1924x1556px. 200-degree field of view: 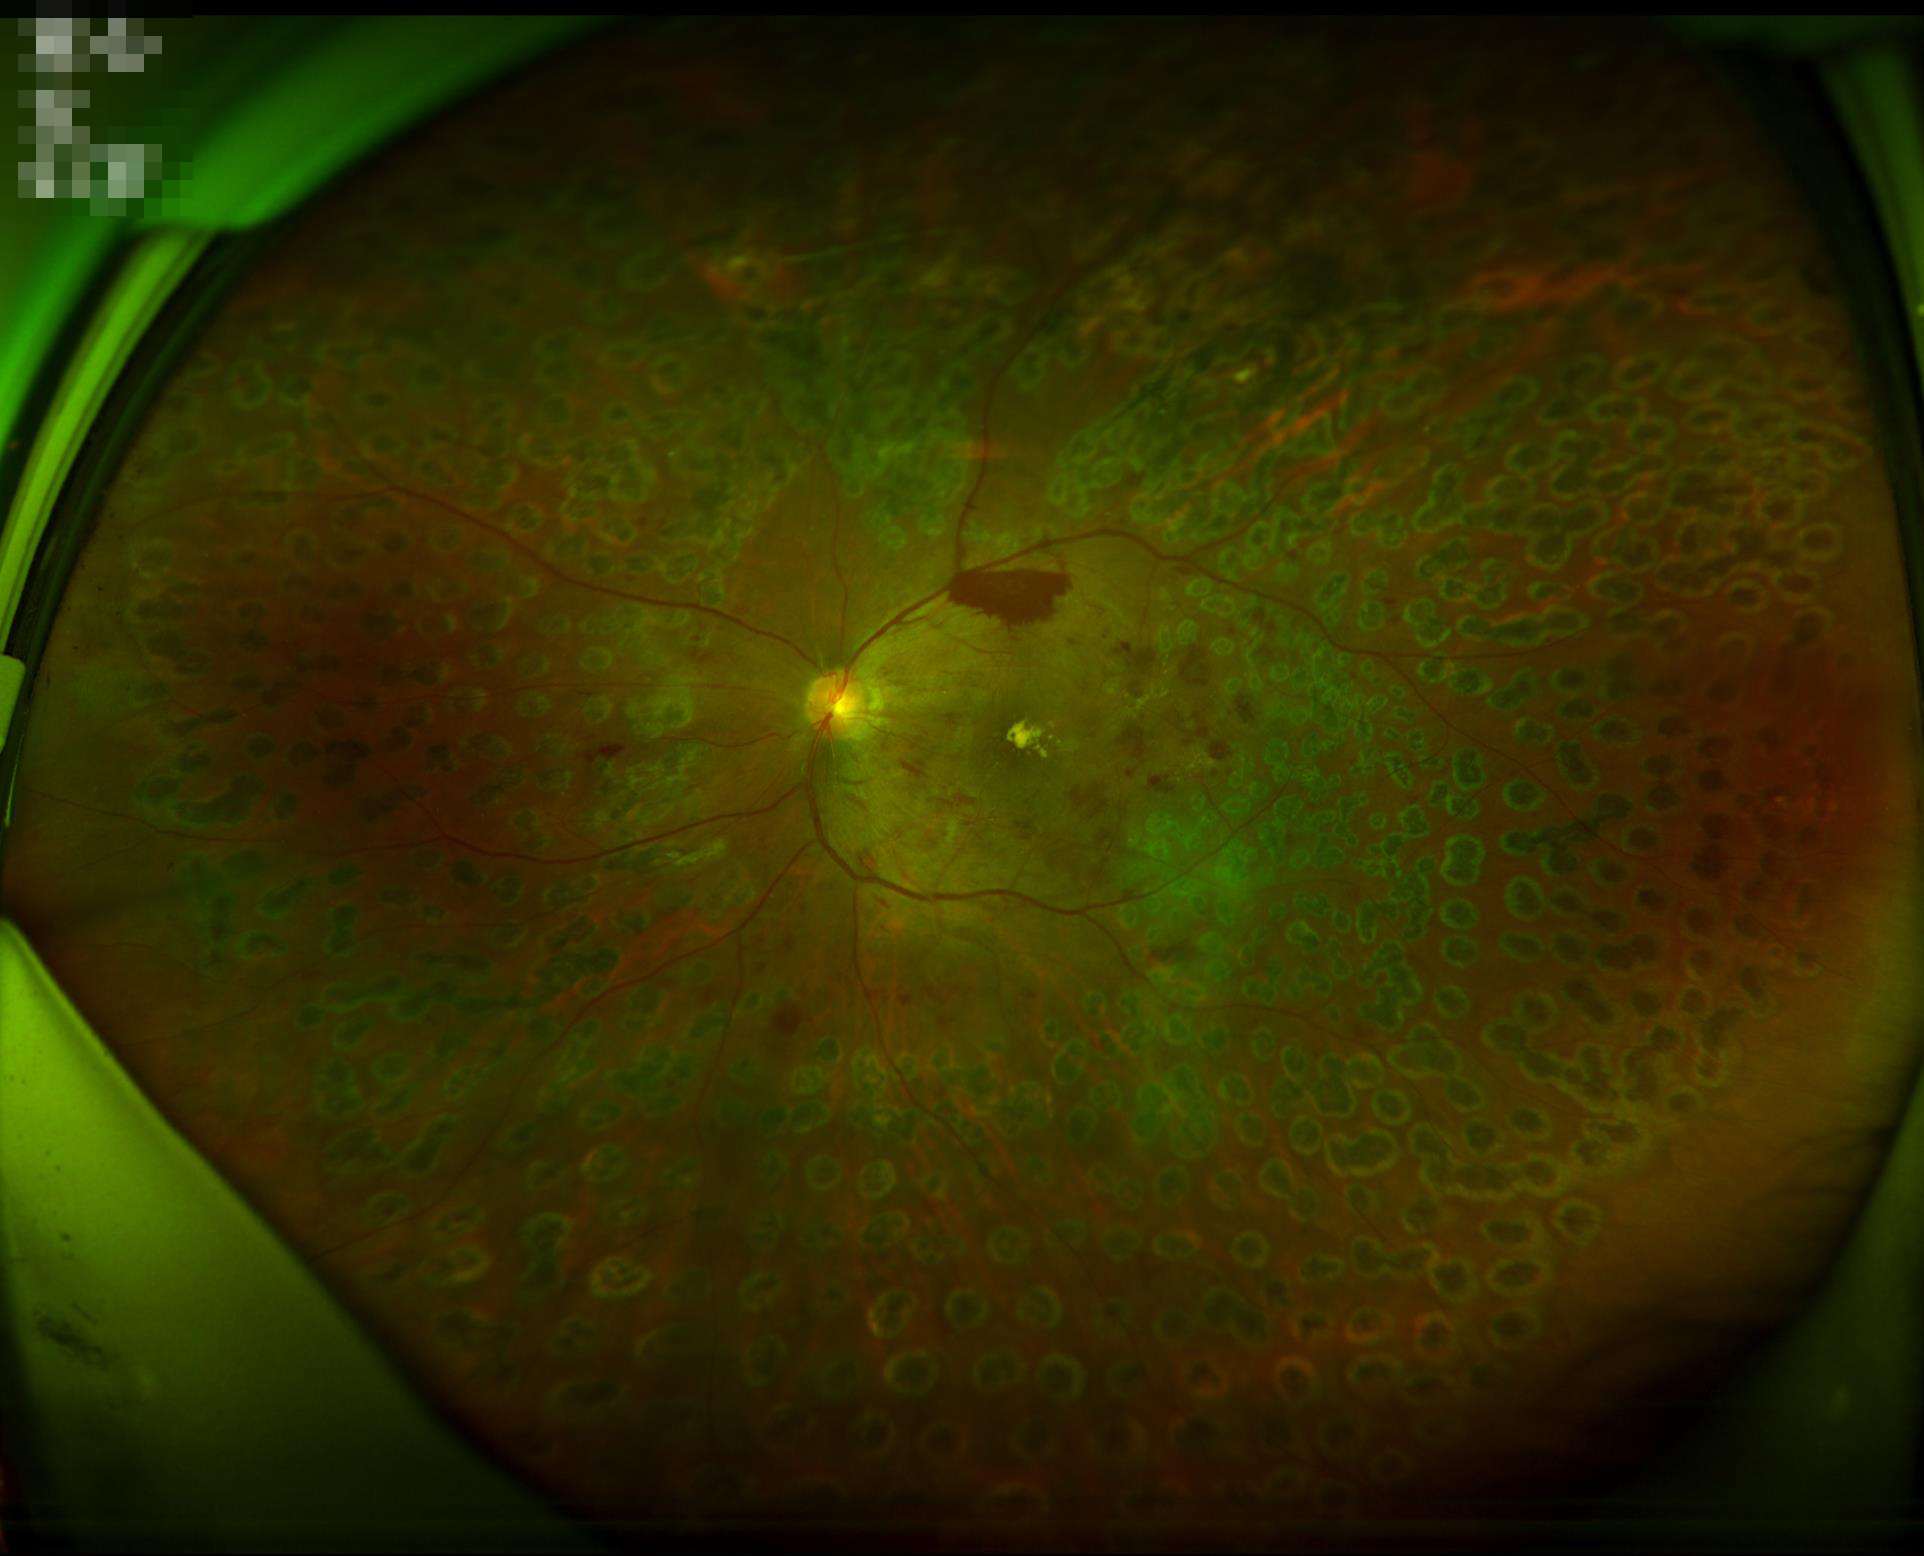
Quality grading:
- overall: adequate
- clarity: sharp
- illumination/color: even